Wide-field contact fundus photograph of an infant · 640x480
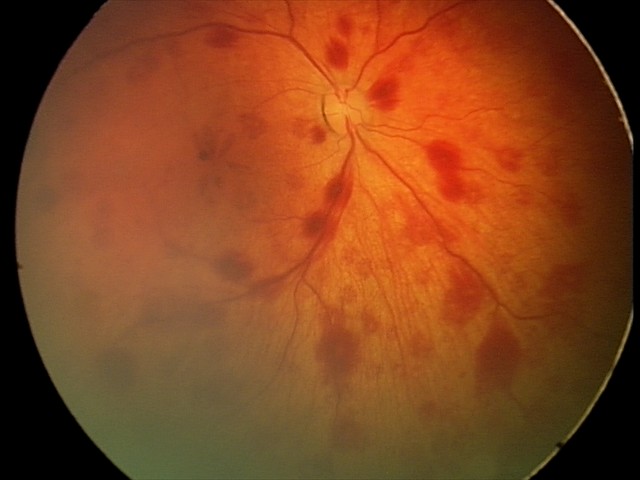 Screening series with retinal hemorrhages.